Pediatric wide-field fundus photograph · camera: Phoenix ICON (100° FOV).
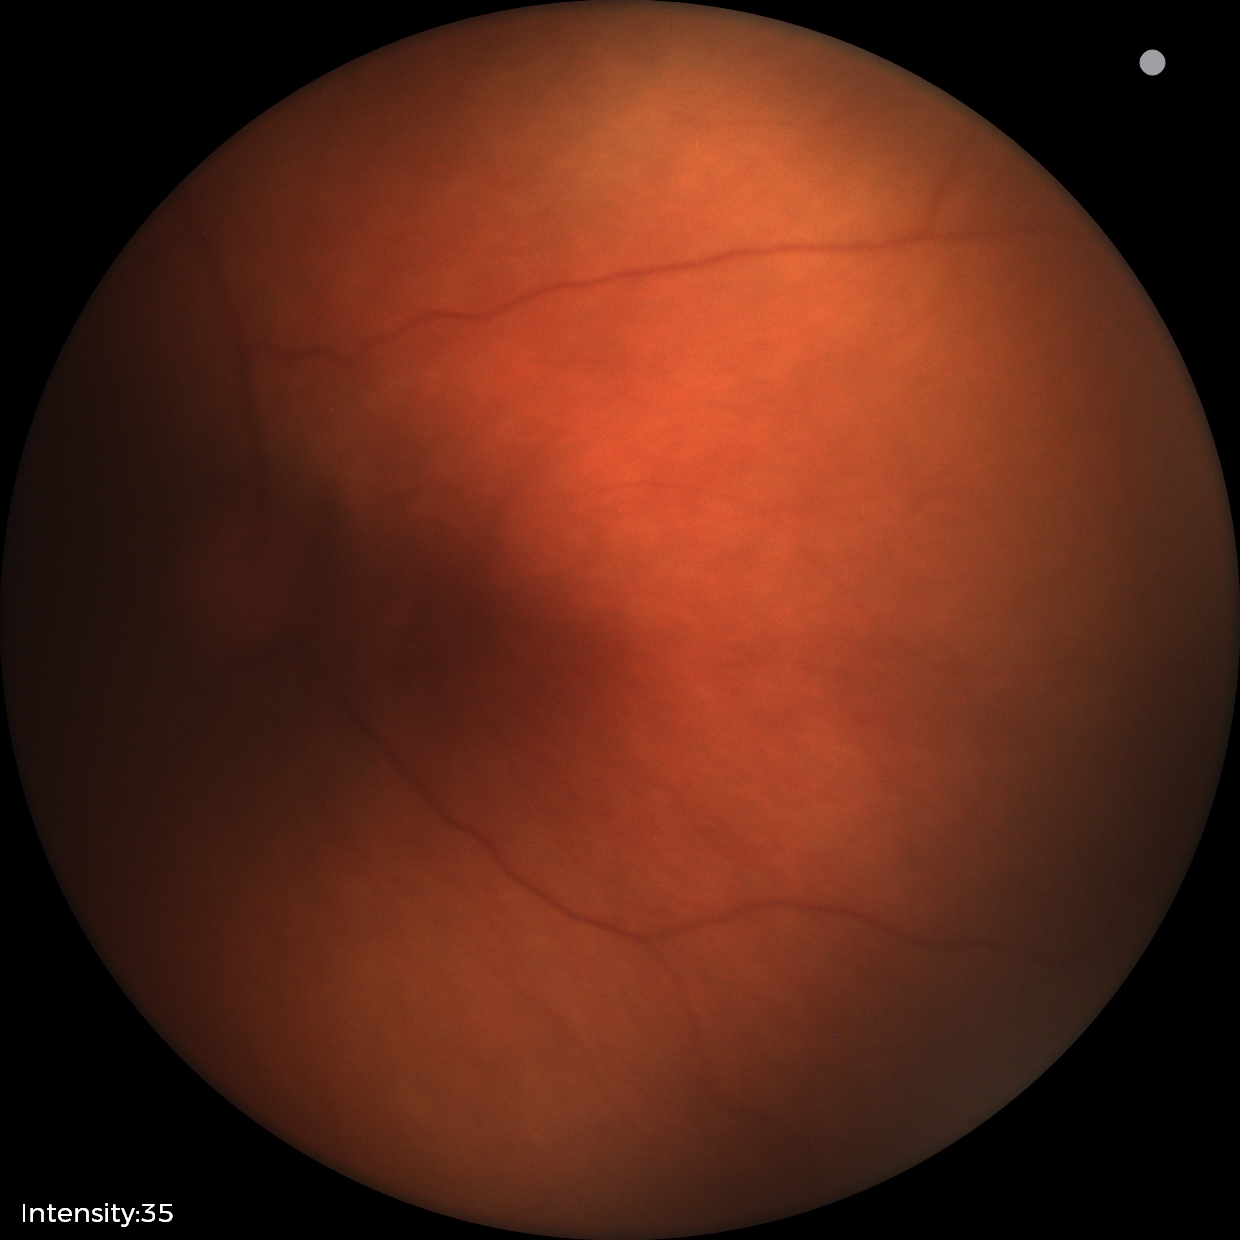 No retinal pathology identified on screening.